Retinal fundus photograph — 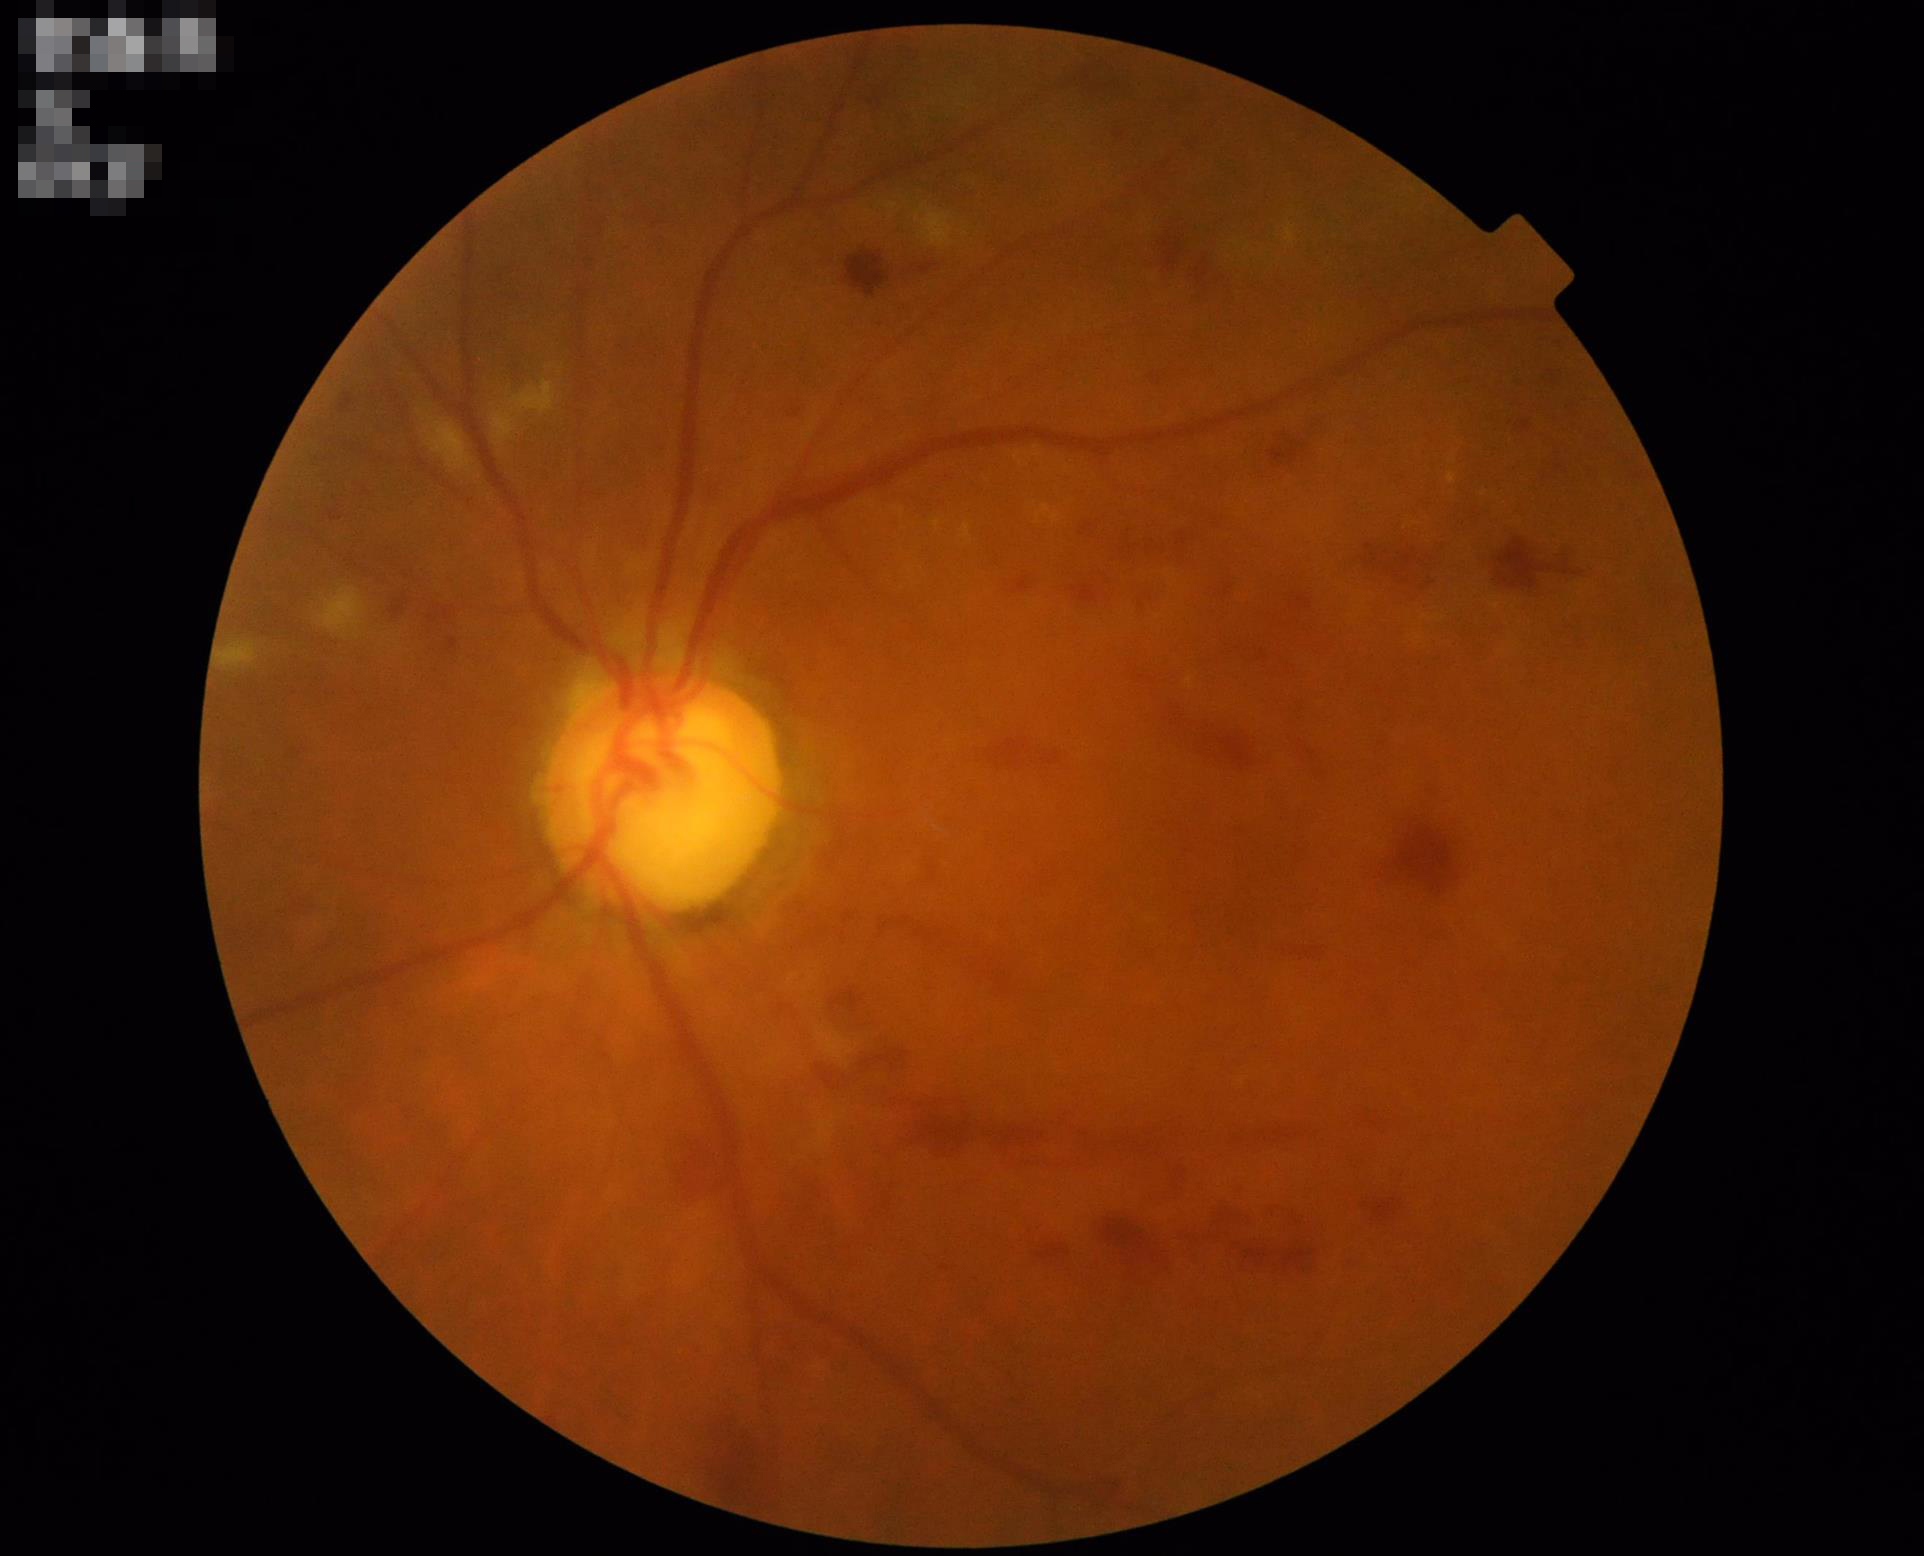
Contrast = reduced | Illumination/color = even | Overall = satisfactory.